Retinal fundus photograph, 45° FOV, 2352x1568: 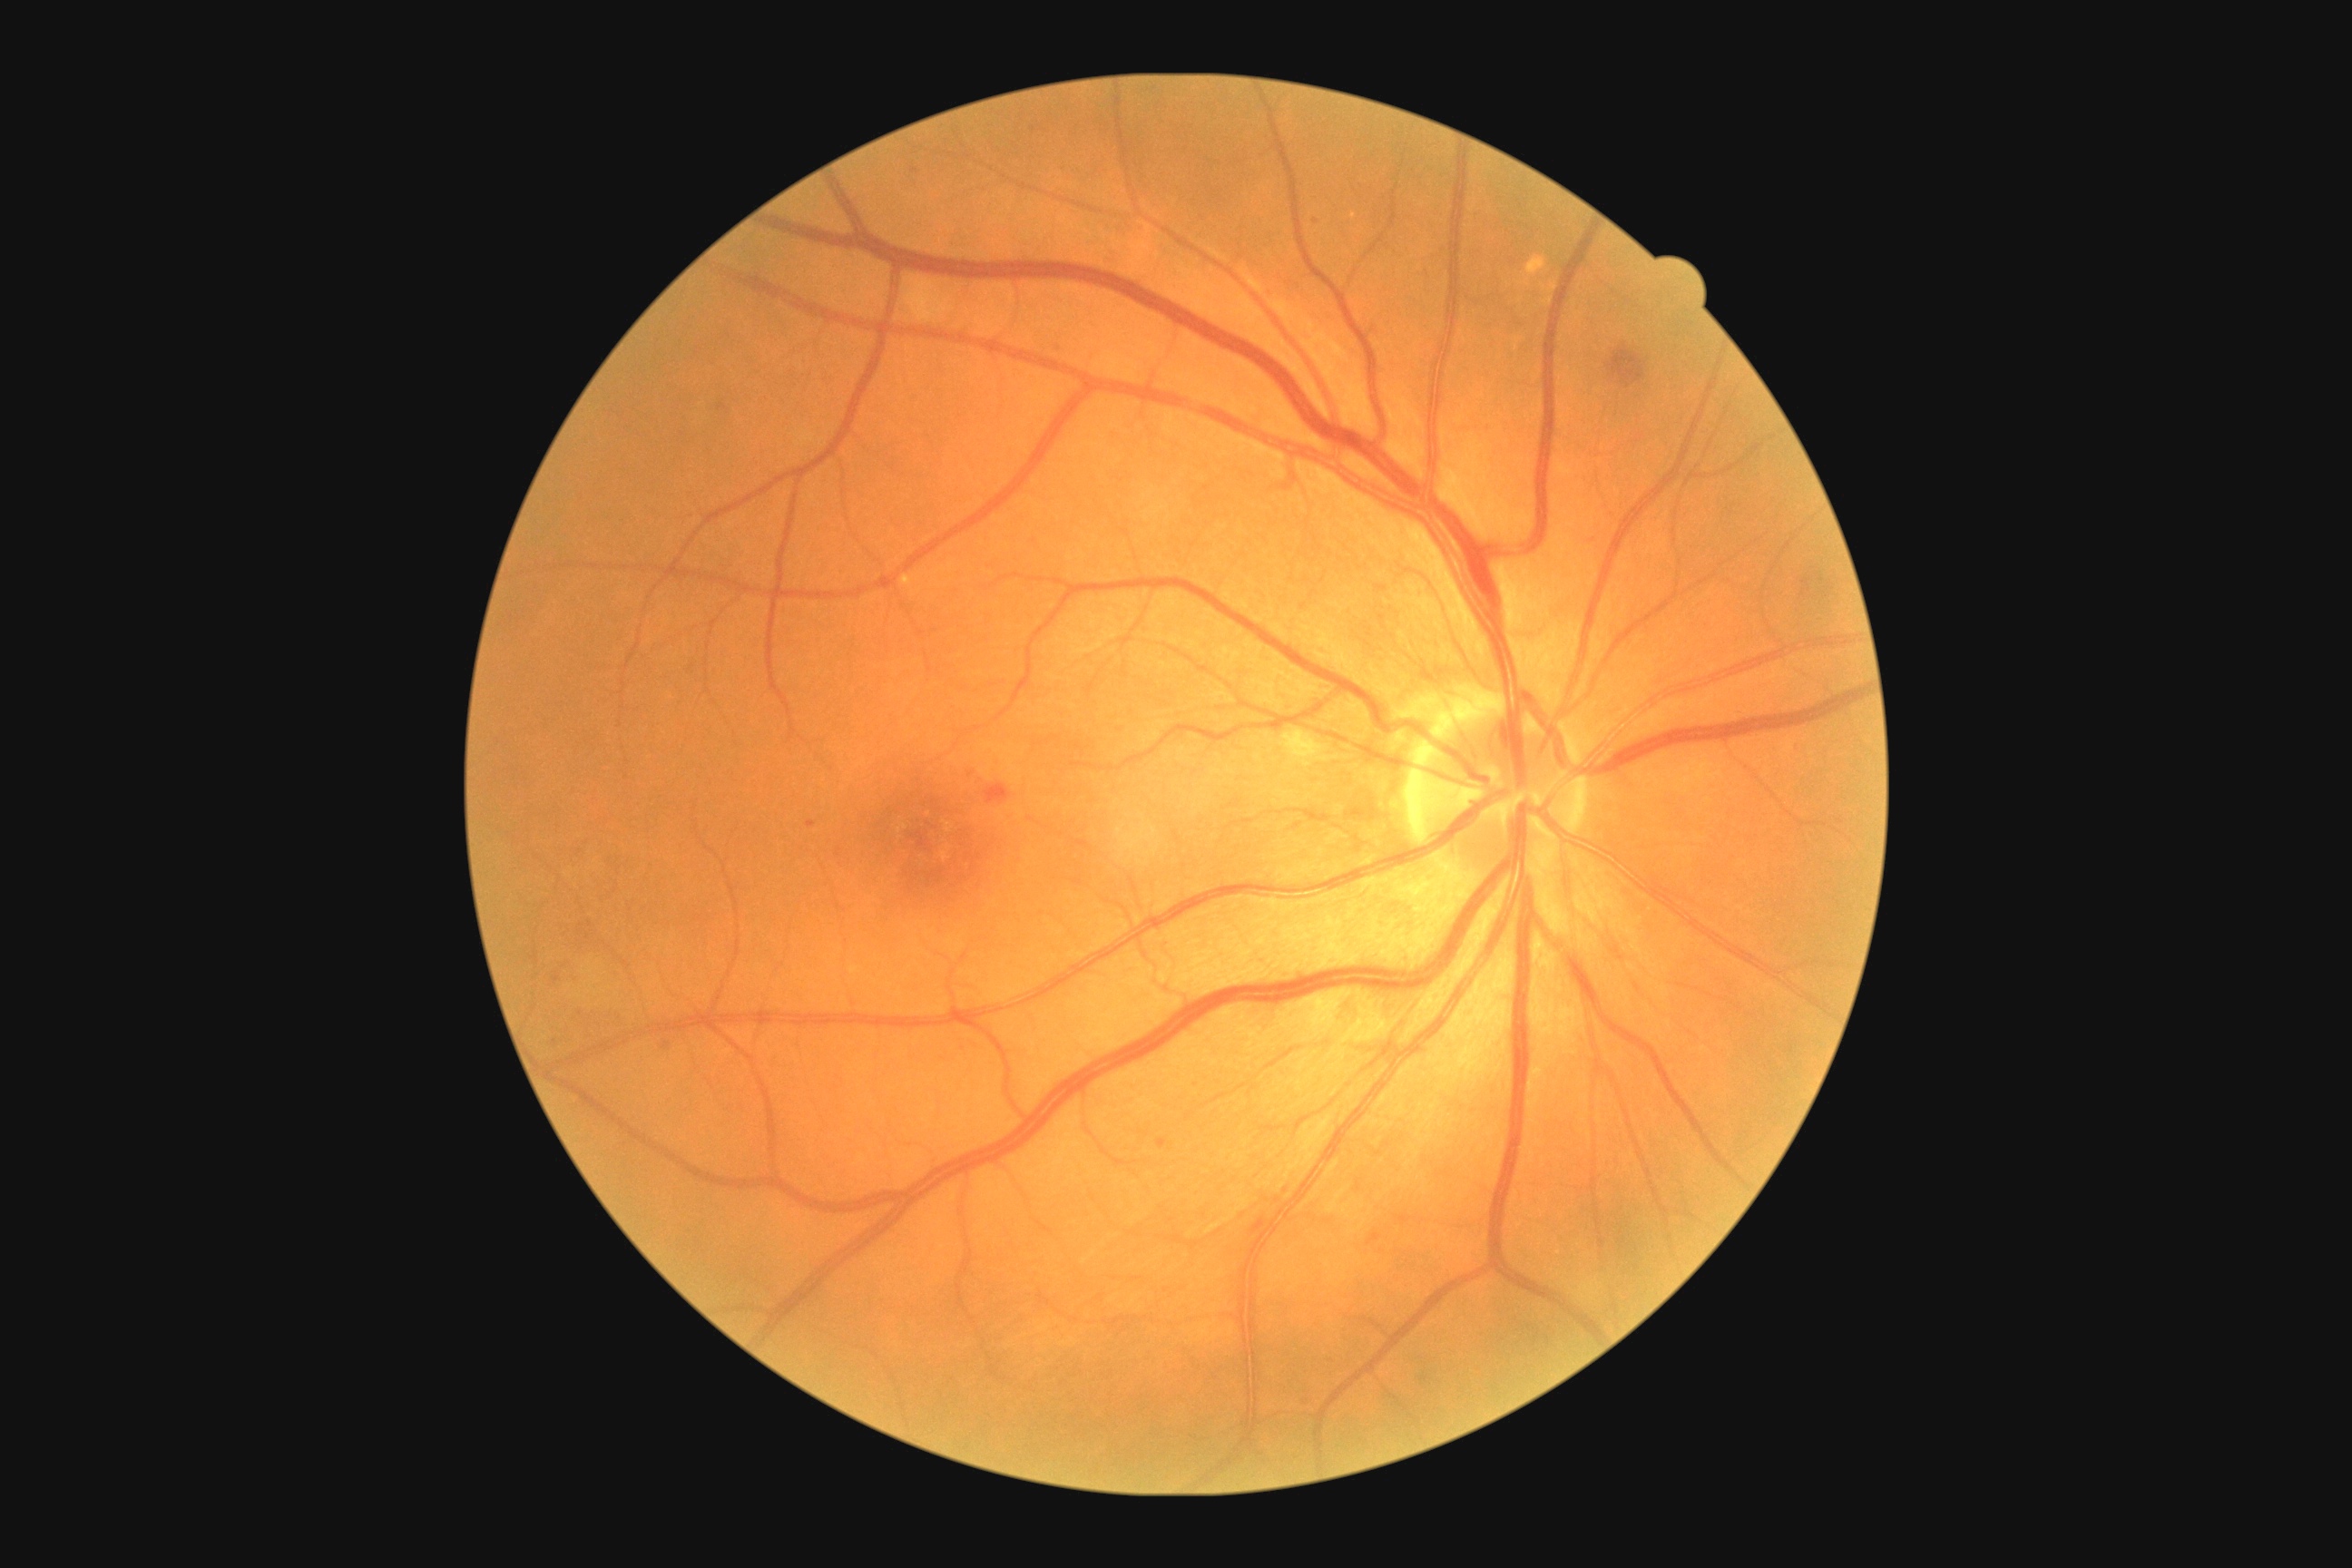

Diabetic retinopathy (DR): grade 2. No soft exudates (SEs) identified. No hard exudates (EXs) identified. No microaneurysms (MAs) identified. Hemorrhages (HEs) are located at region(1050, 346, 1068, 358); region(1367, 1233, 1382, 1246); region(1157, 1139, 1168, 1150); region(985, 783, 1012, 805); region(1605, 344, 1651, 397); region(807, 821, 816, 828). Small HEs approximately at {"x": 1315, "y": 222}; {"x": 971, "y": 775}; {"x": 915, "y": 170}.